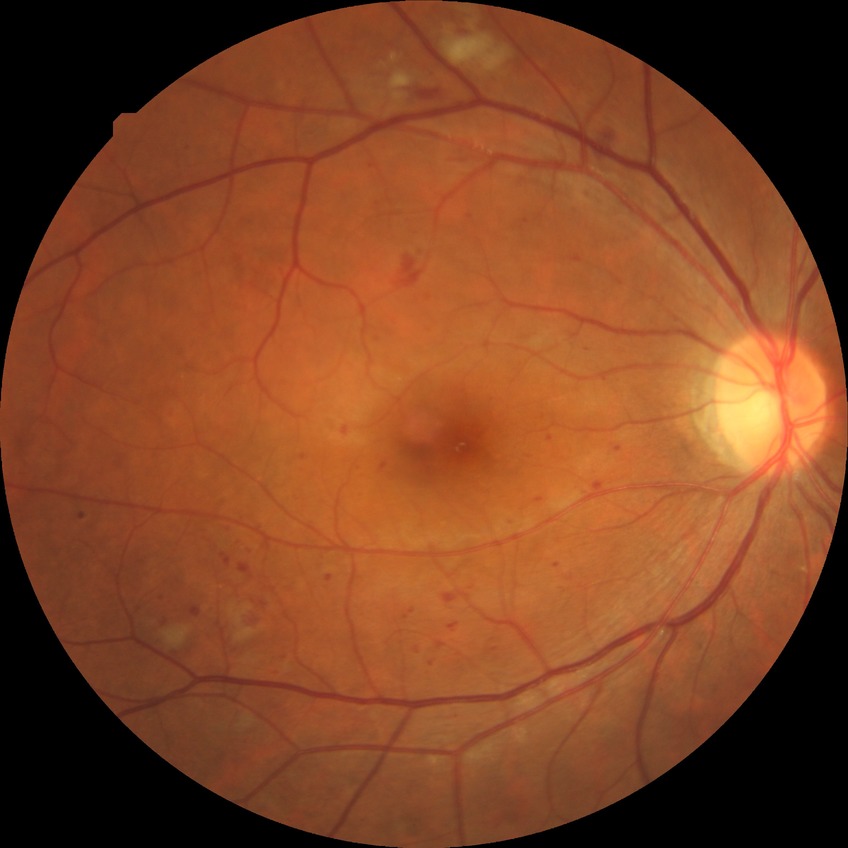 DR class: non-proliferative diabetic retinopathy. Modified Davis grade: PPDR.